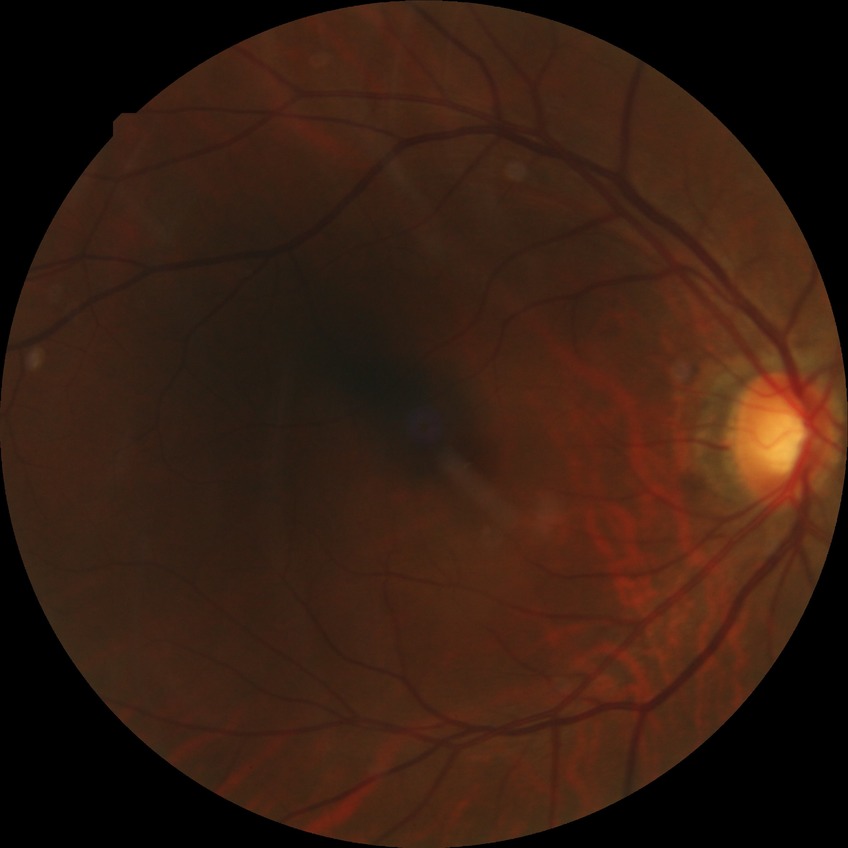 Diabetic retinopathy stage is simple diabetic retinopathy.